Retinal fundus photograph.
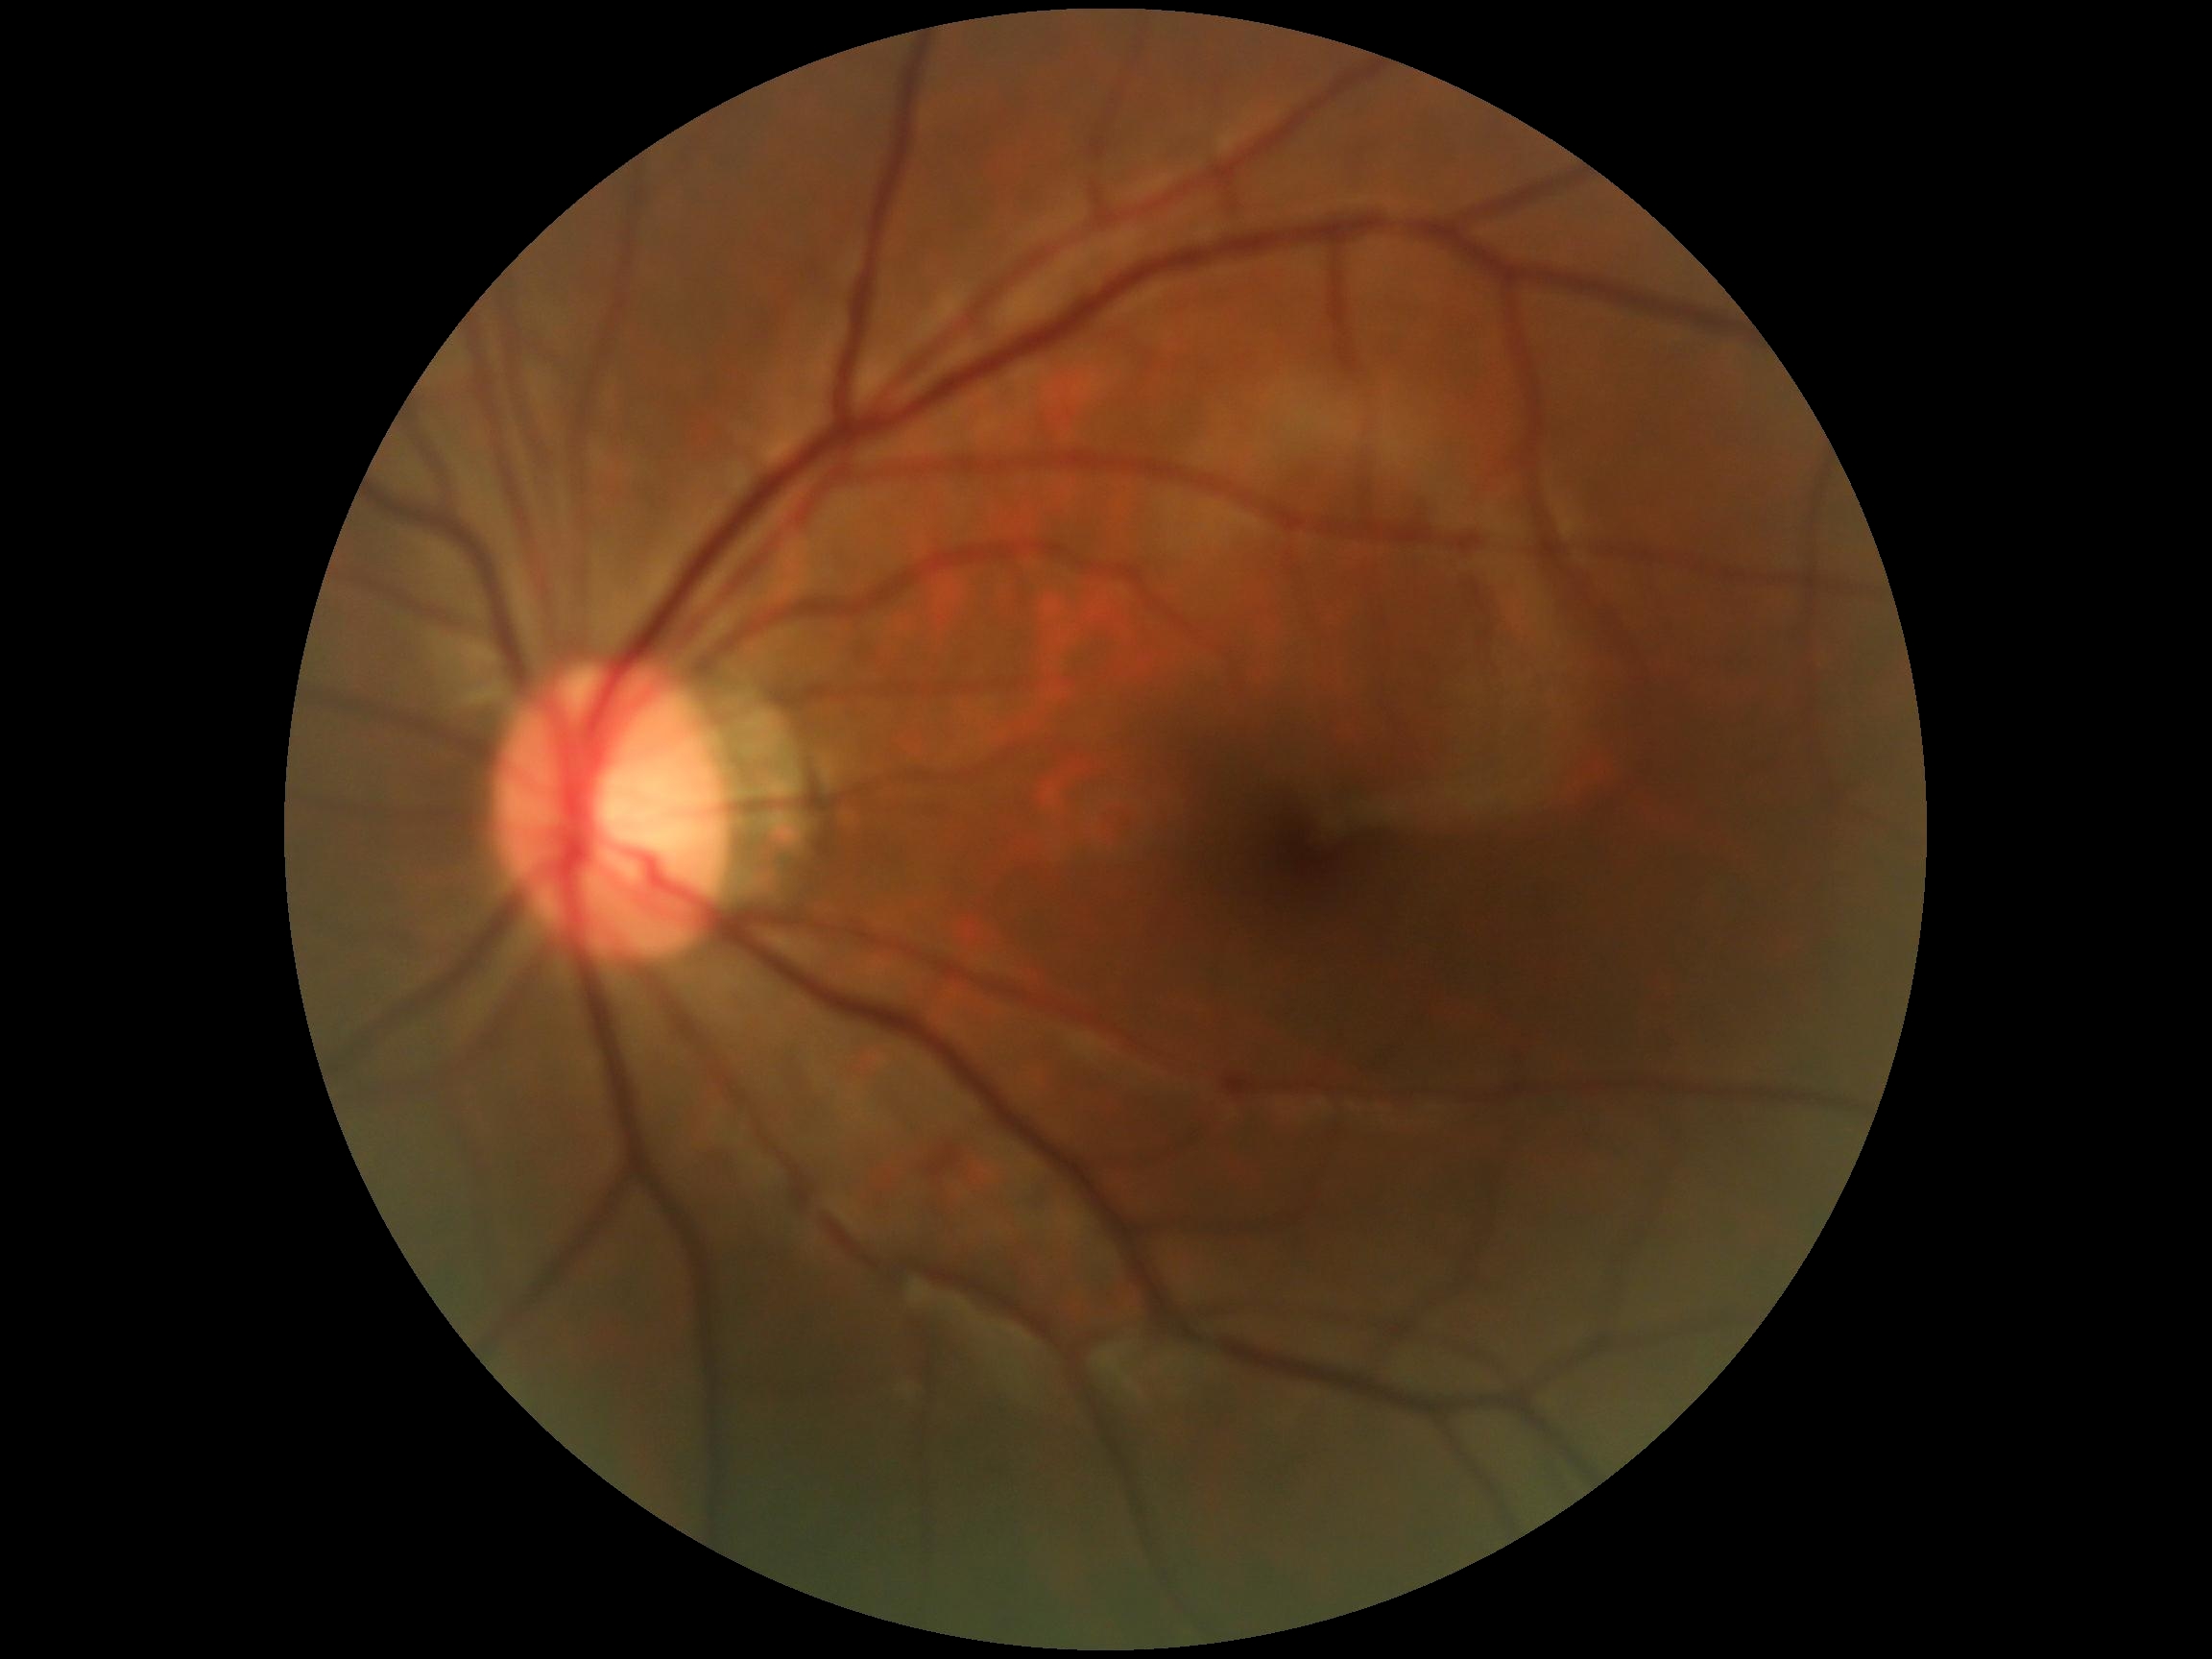

Diabetic retinopathy (DR): 0.